Non-mydriatic acquisition; optic disc at the center of the field
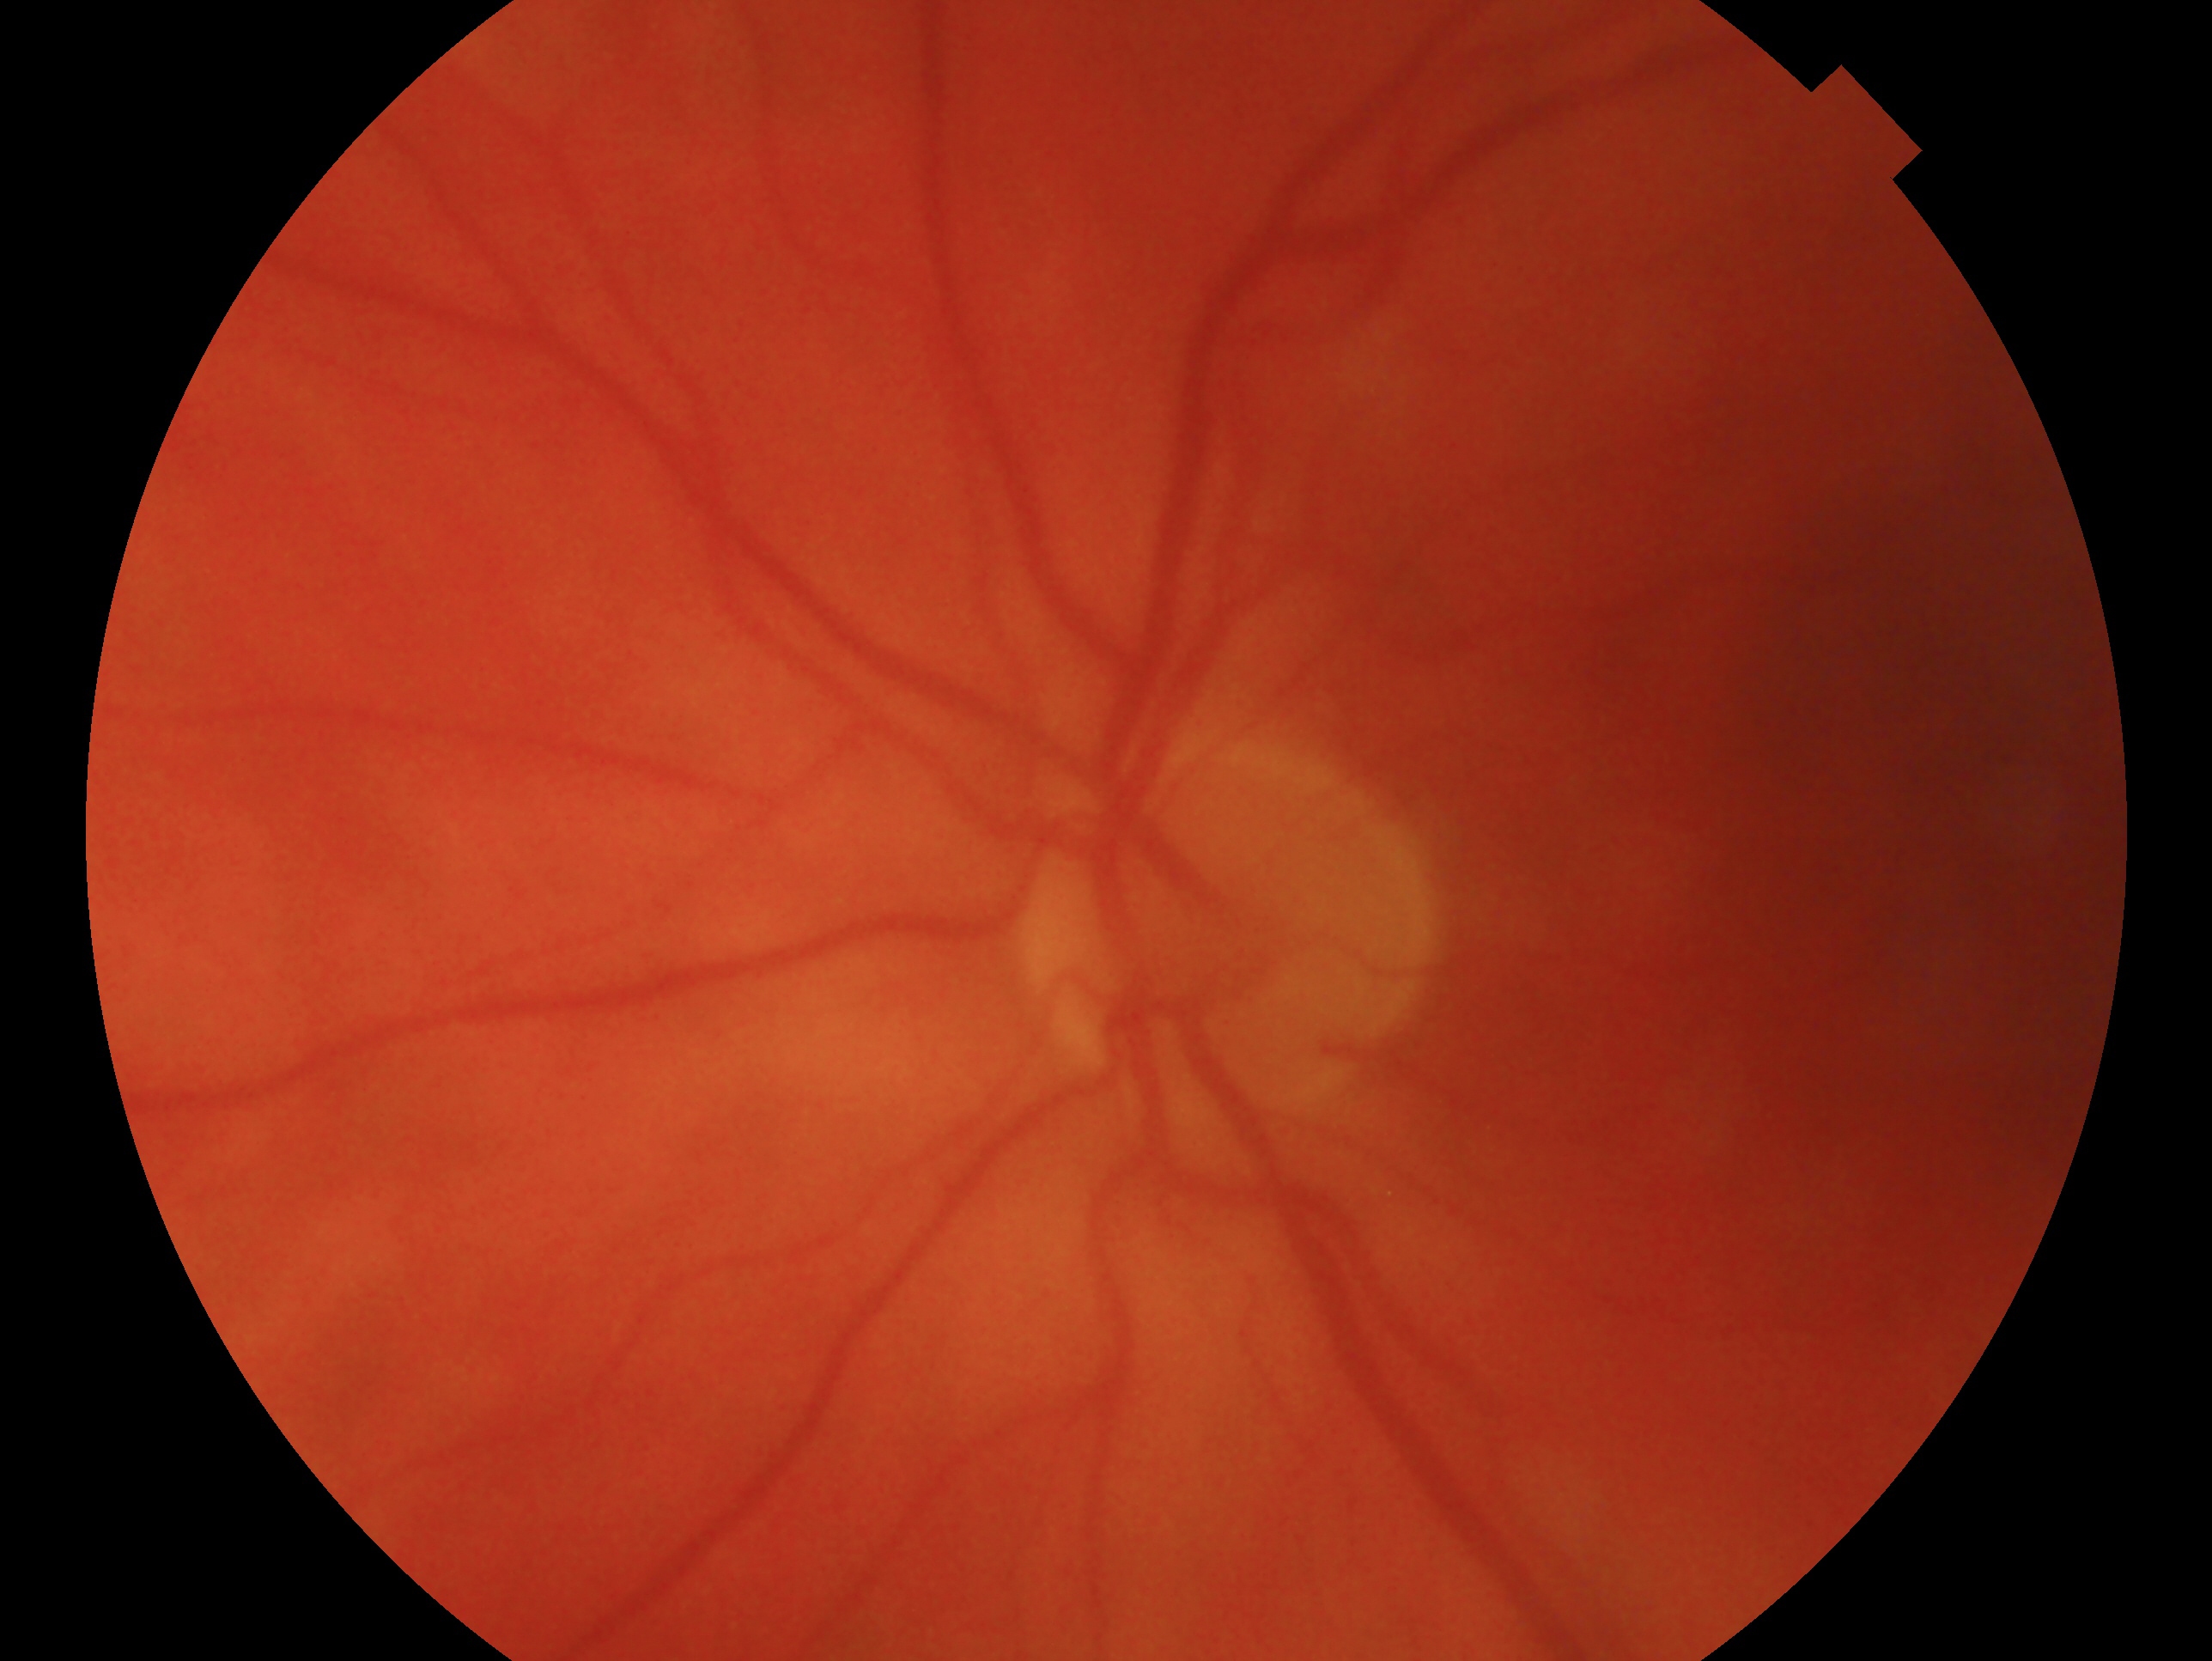
The image shows the left eye. Clinical classification: no evidence of glaucoma.